UWF retinal mosaic
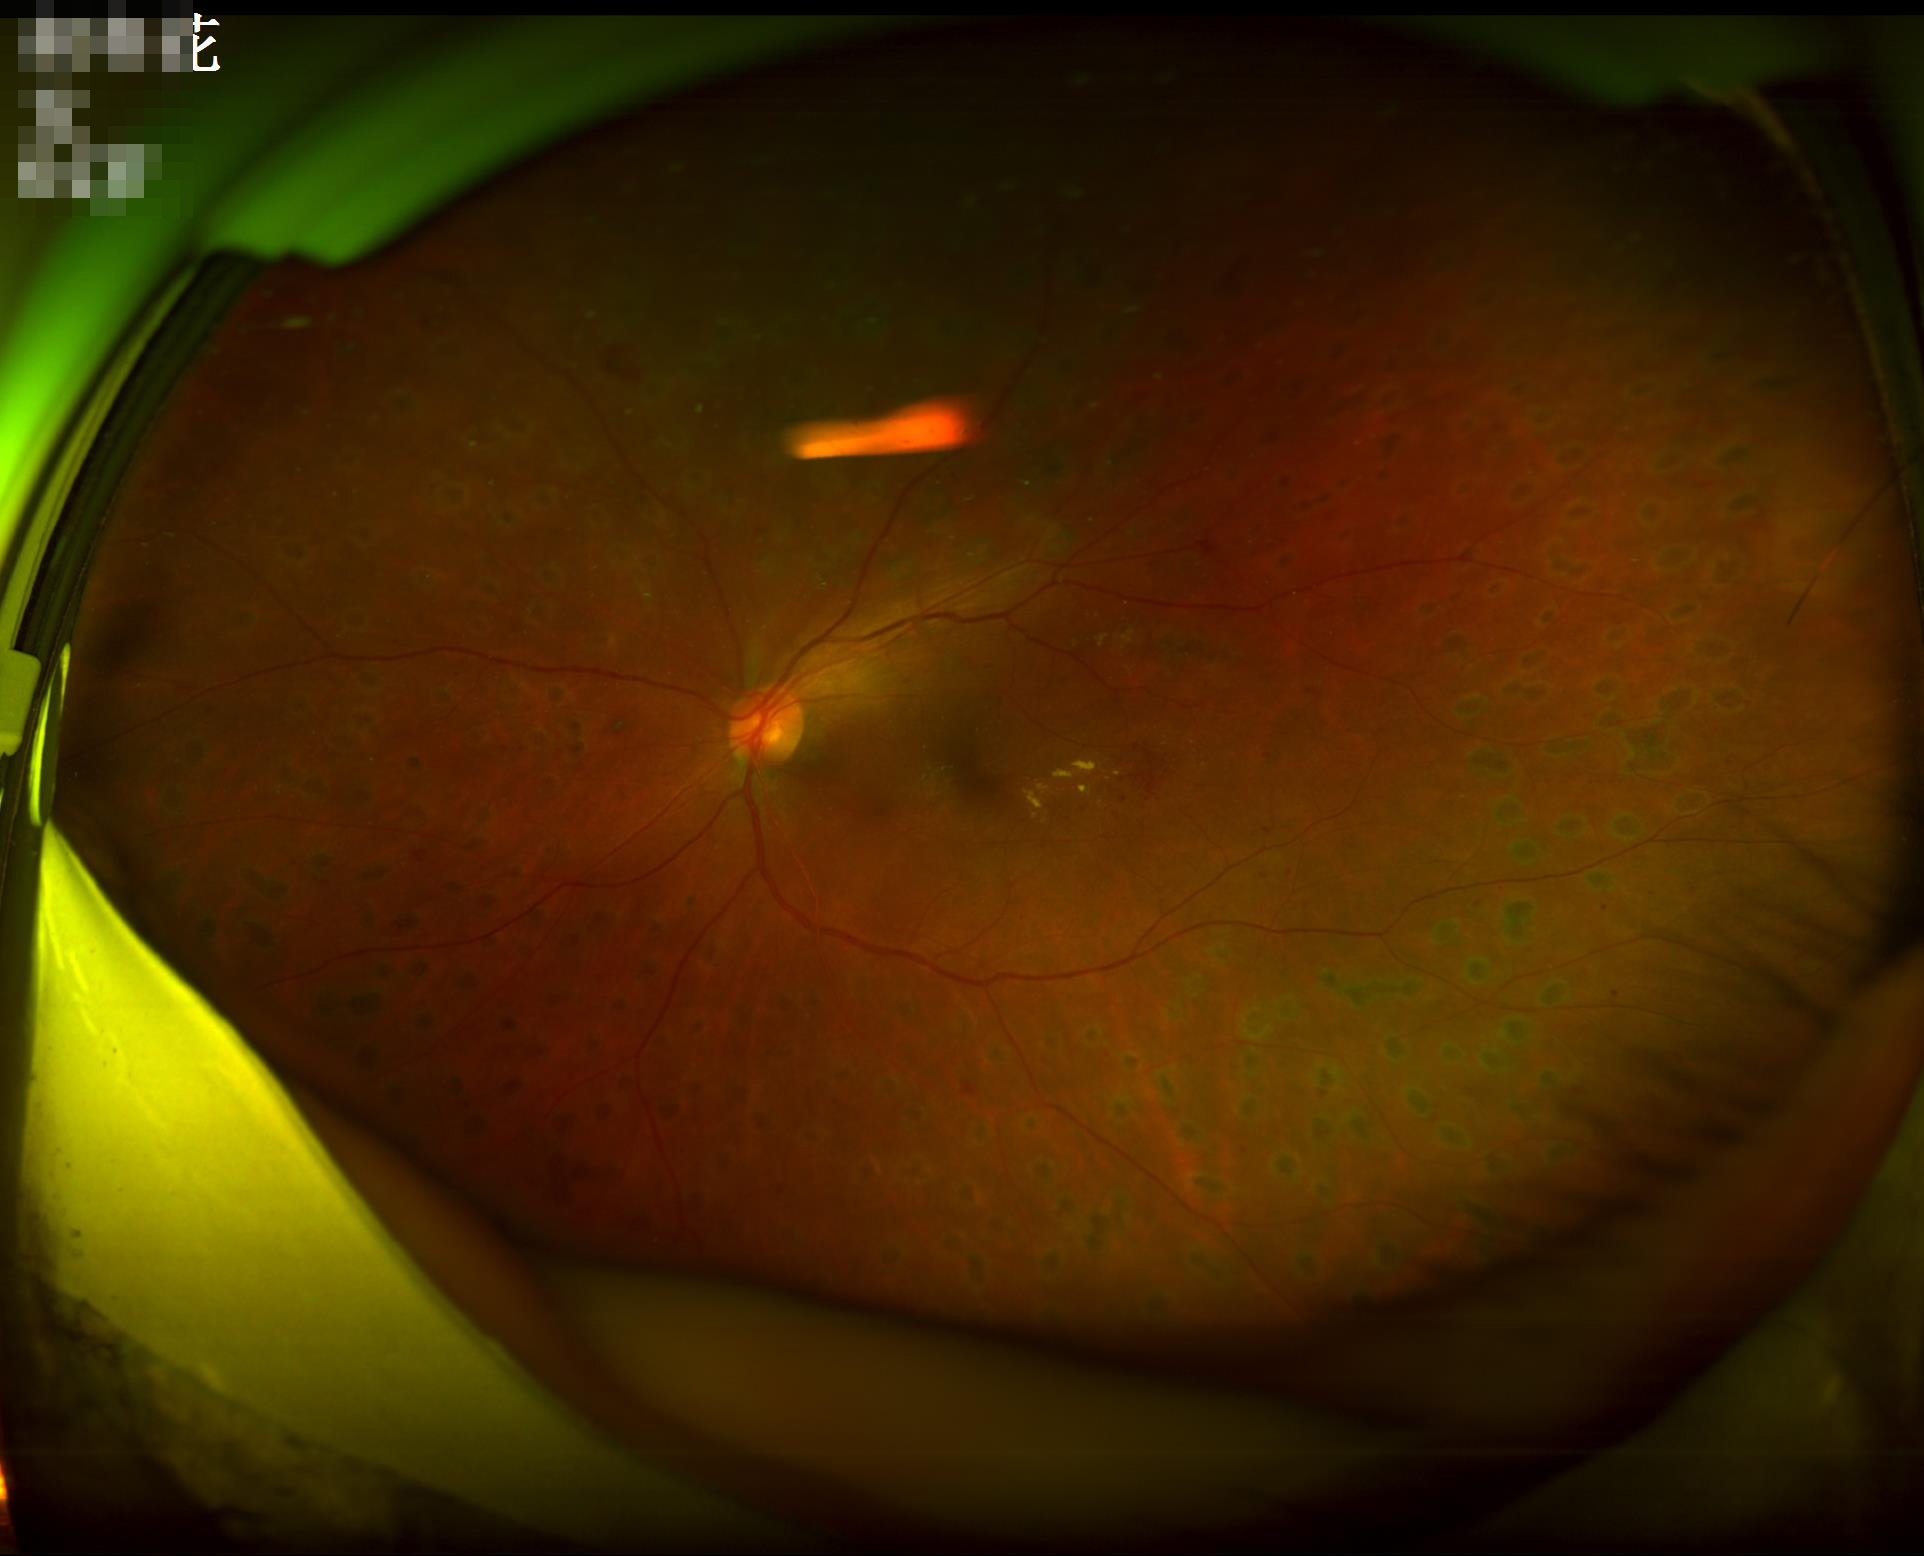

Illumination = uneven illumination or color cast | Contrast = vessels and details readily distinguishable | Sharpness = sharp throughout the field | Overall image quality = adequate for clinical interpretation.